Color fundus image:
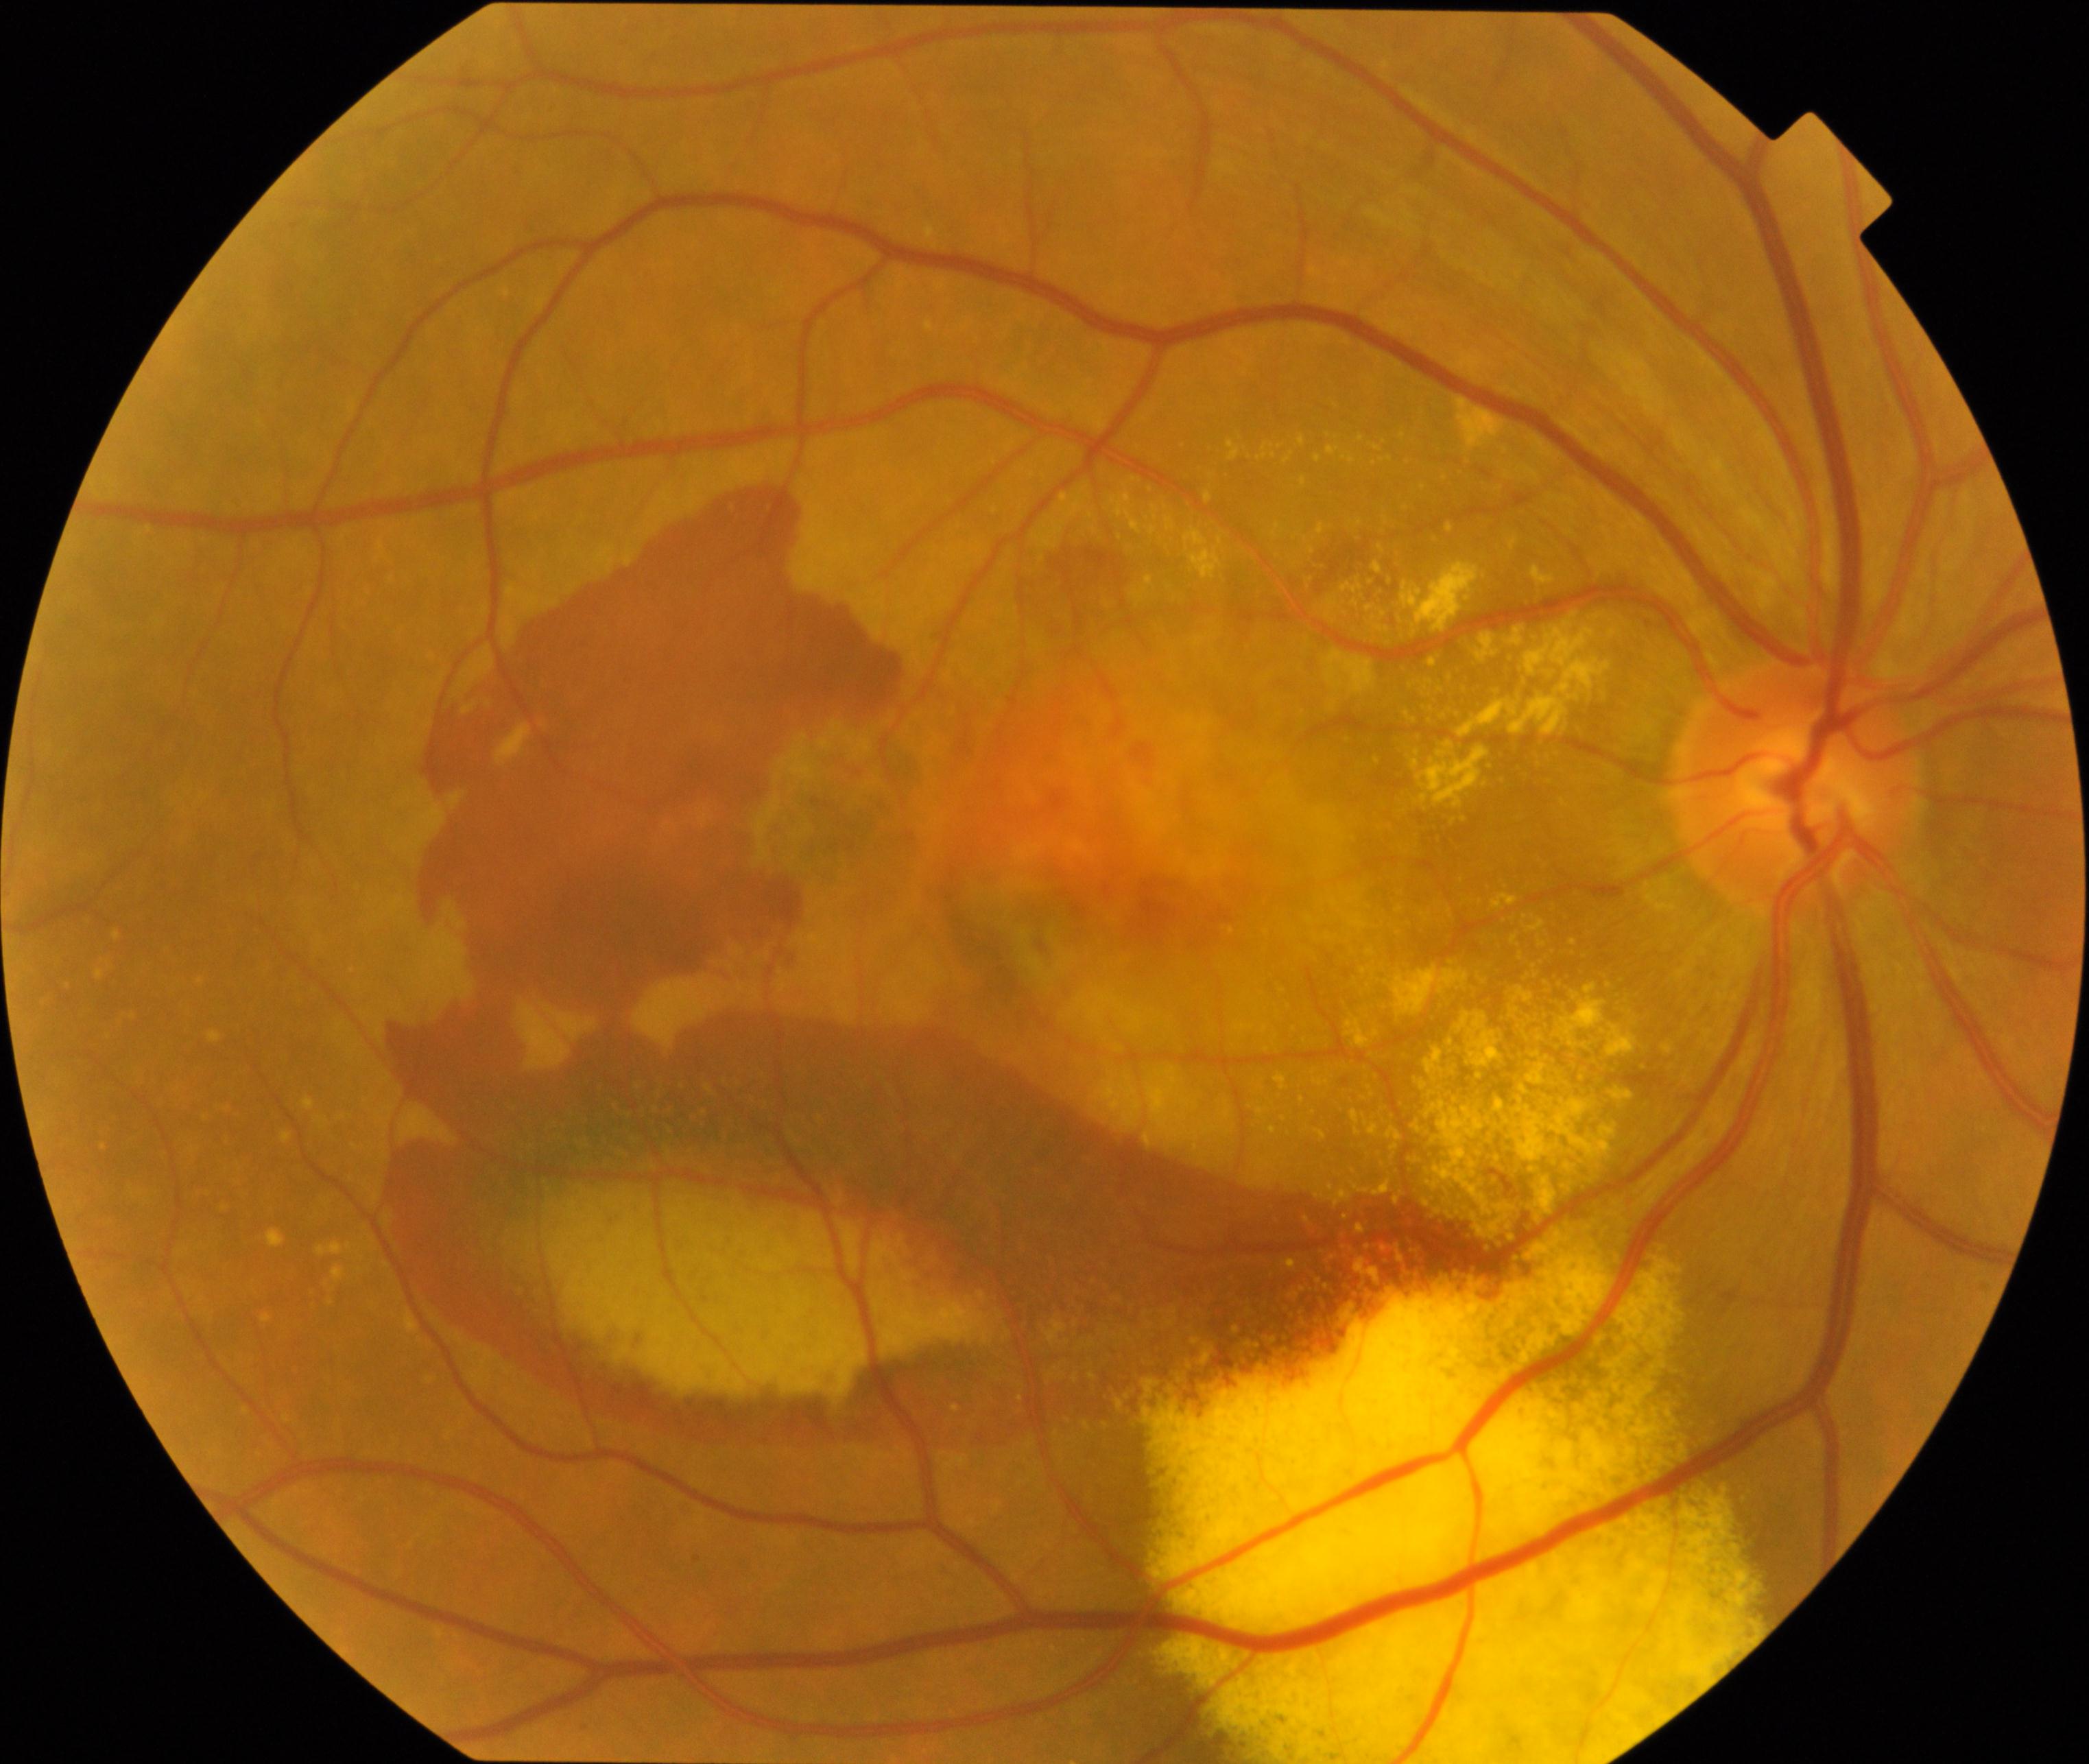 Classification: maculopathy.